Color fundus photograph. Nonmydriatic. Davis DR grading.
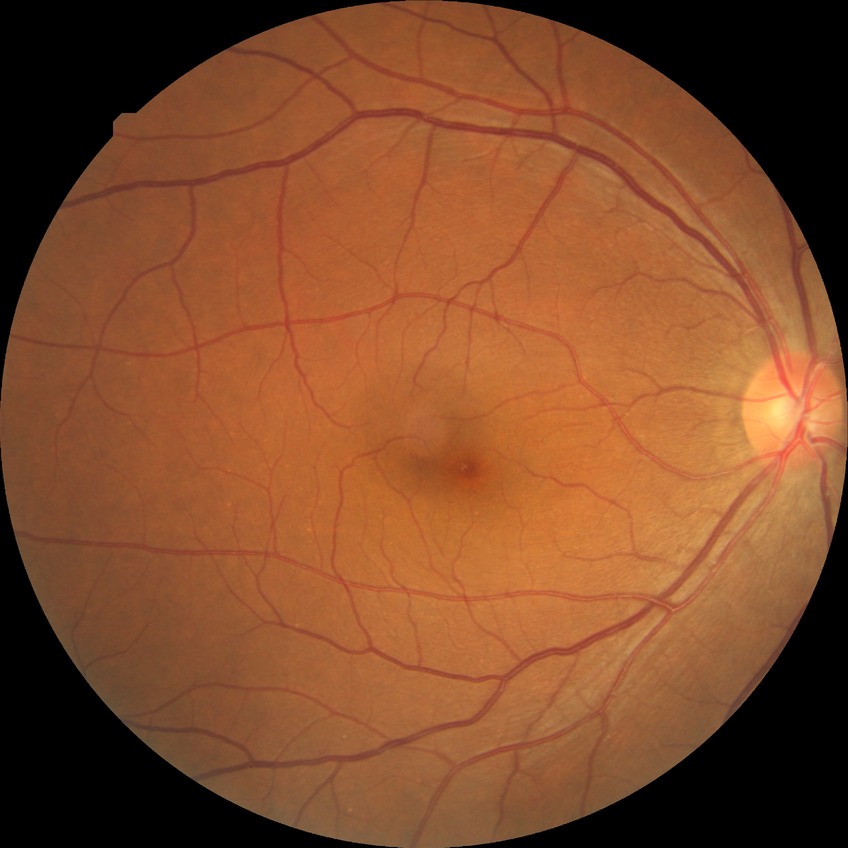 Diabetic retinopathy severity: no diabetic retinopathy.